Pediatric wide-field fundus photograph
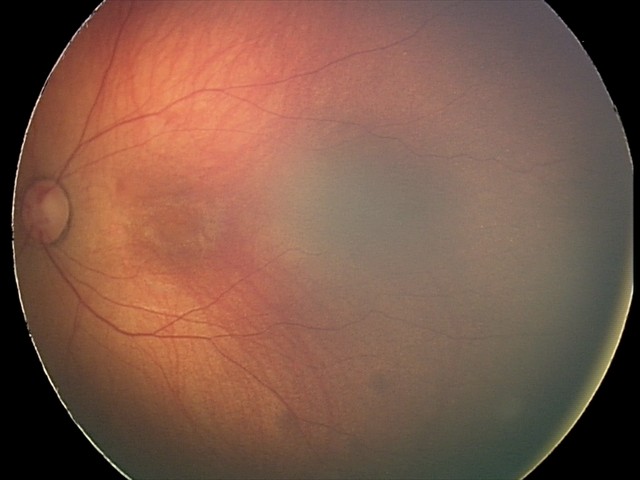
Impression = retinal hemorrhages.